Captured with the Clarity RetCam 3 (130° field of view) · pediatric wide-field fundus photograph · image size 640x480
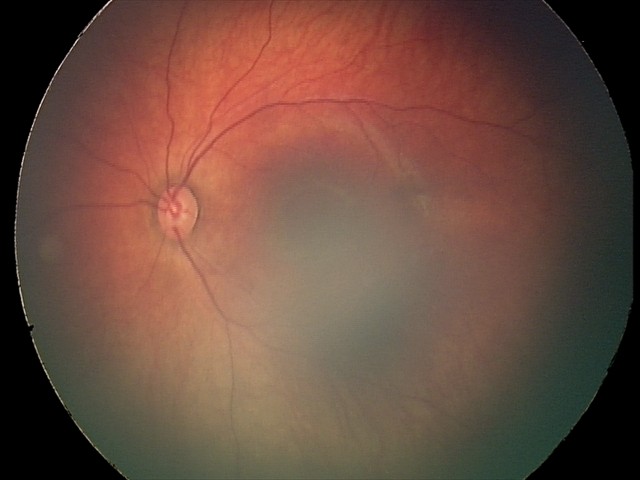 Diagnosis from this screening exam: retinal hemorrhages.